Pediatric wide-field fundus photograph:
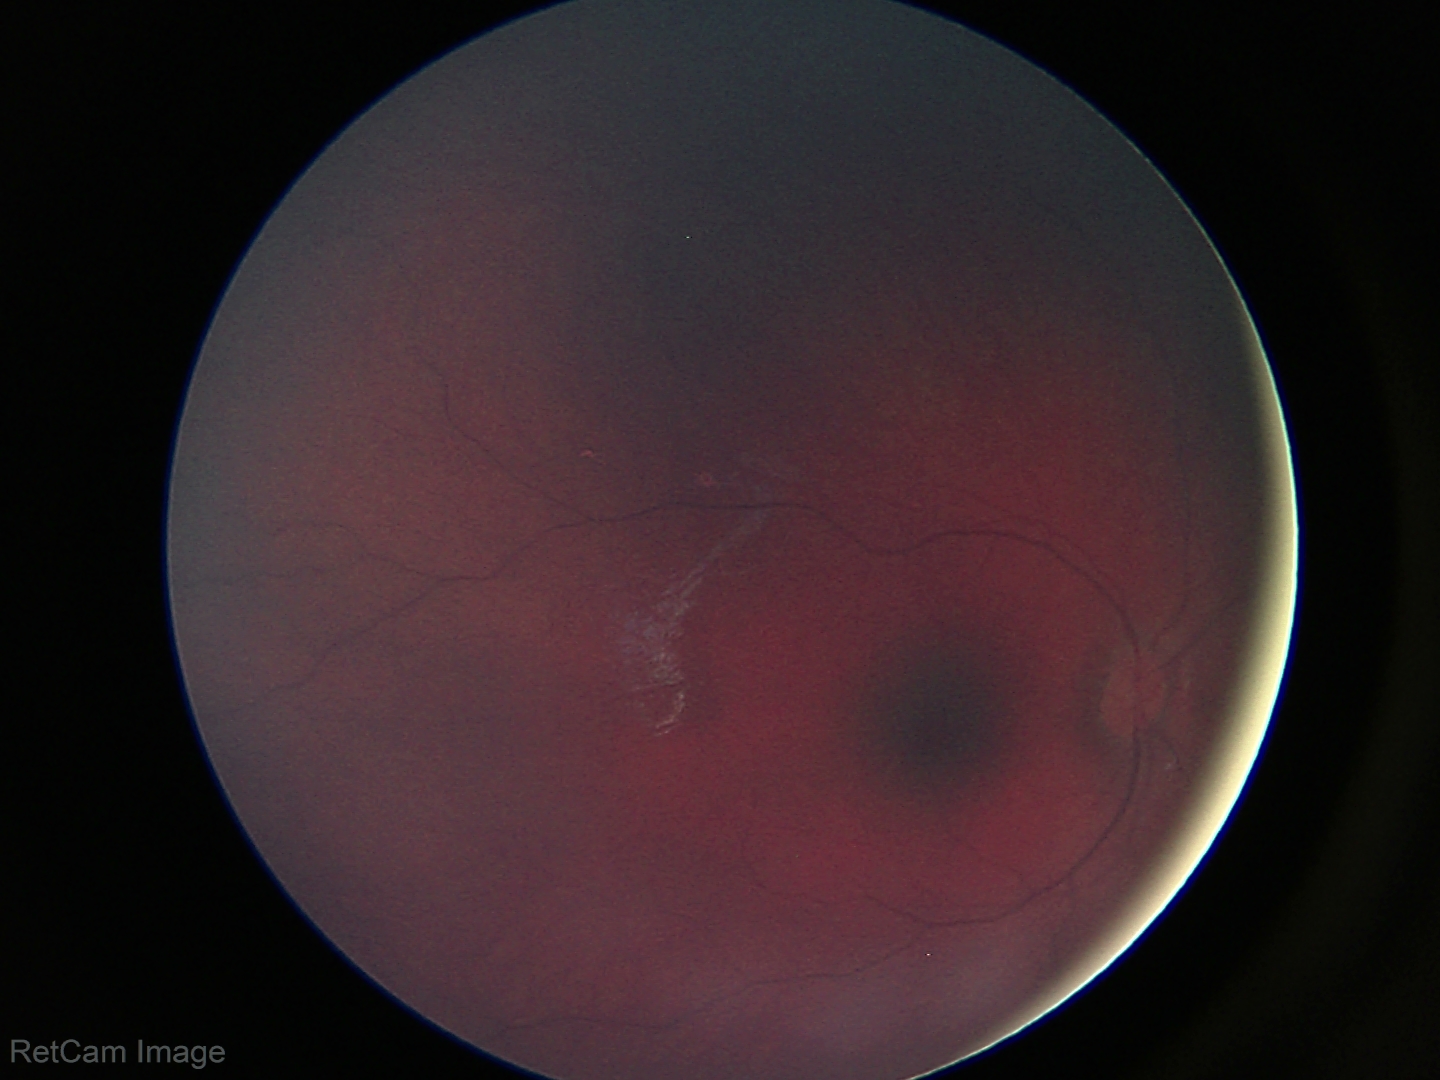 Screening examination diagnosed as physiological.